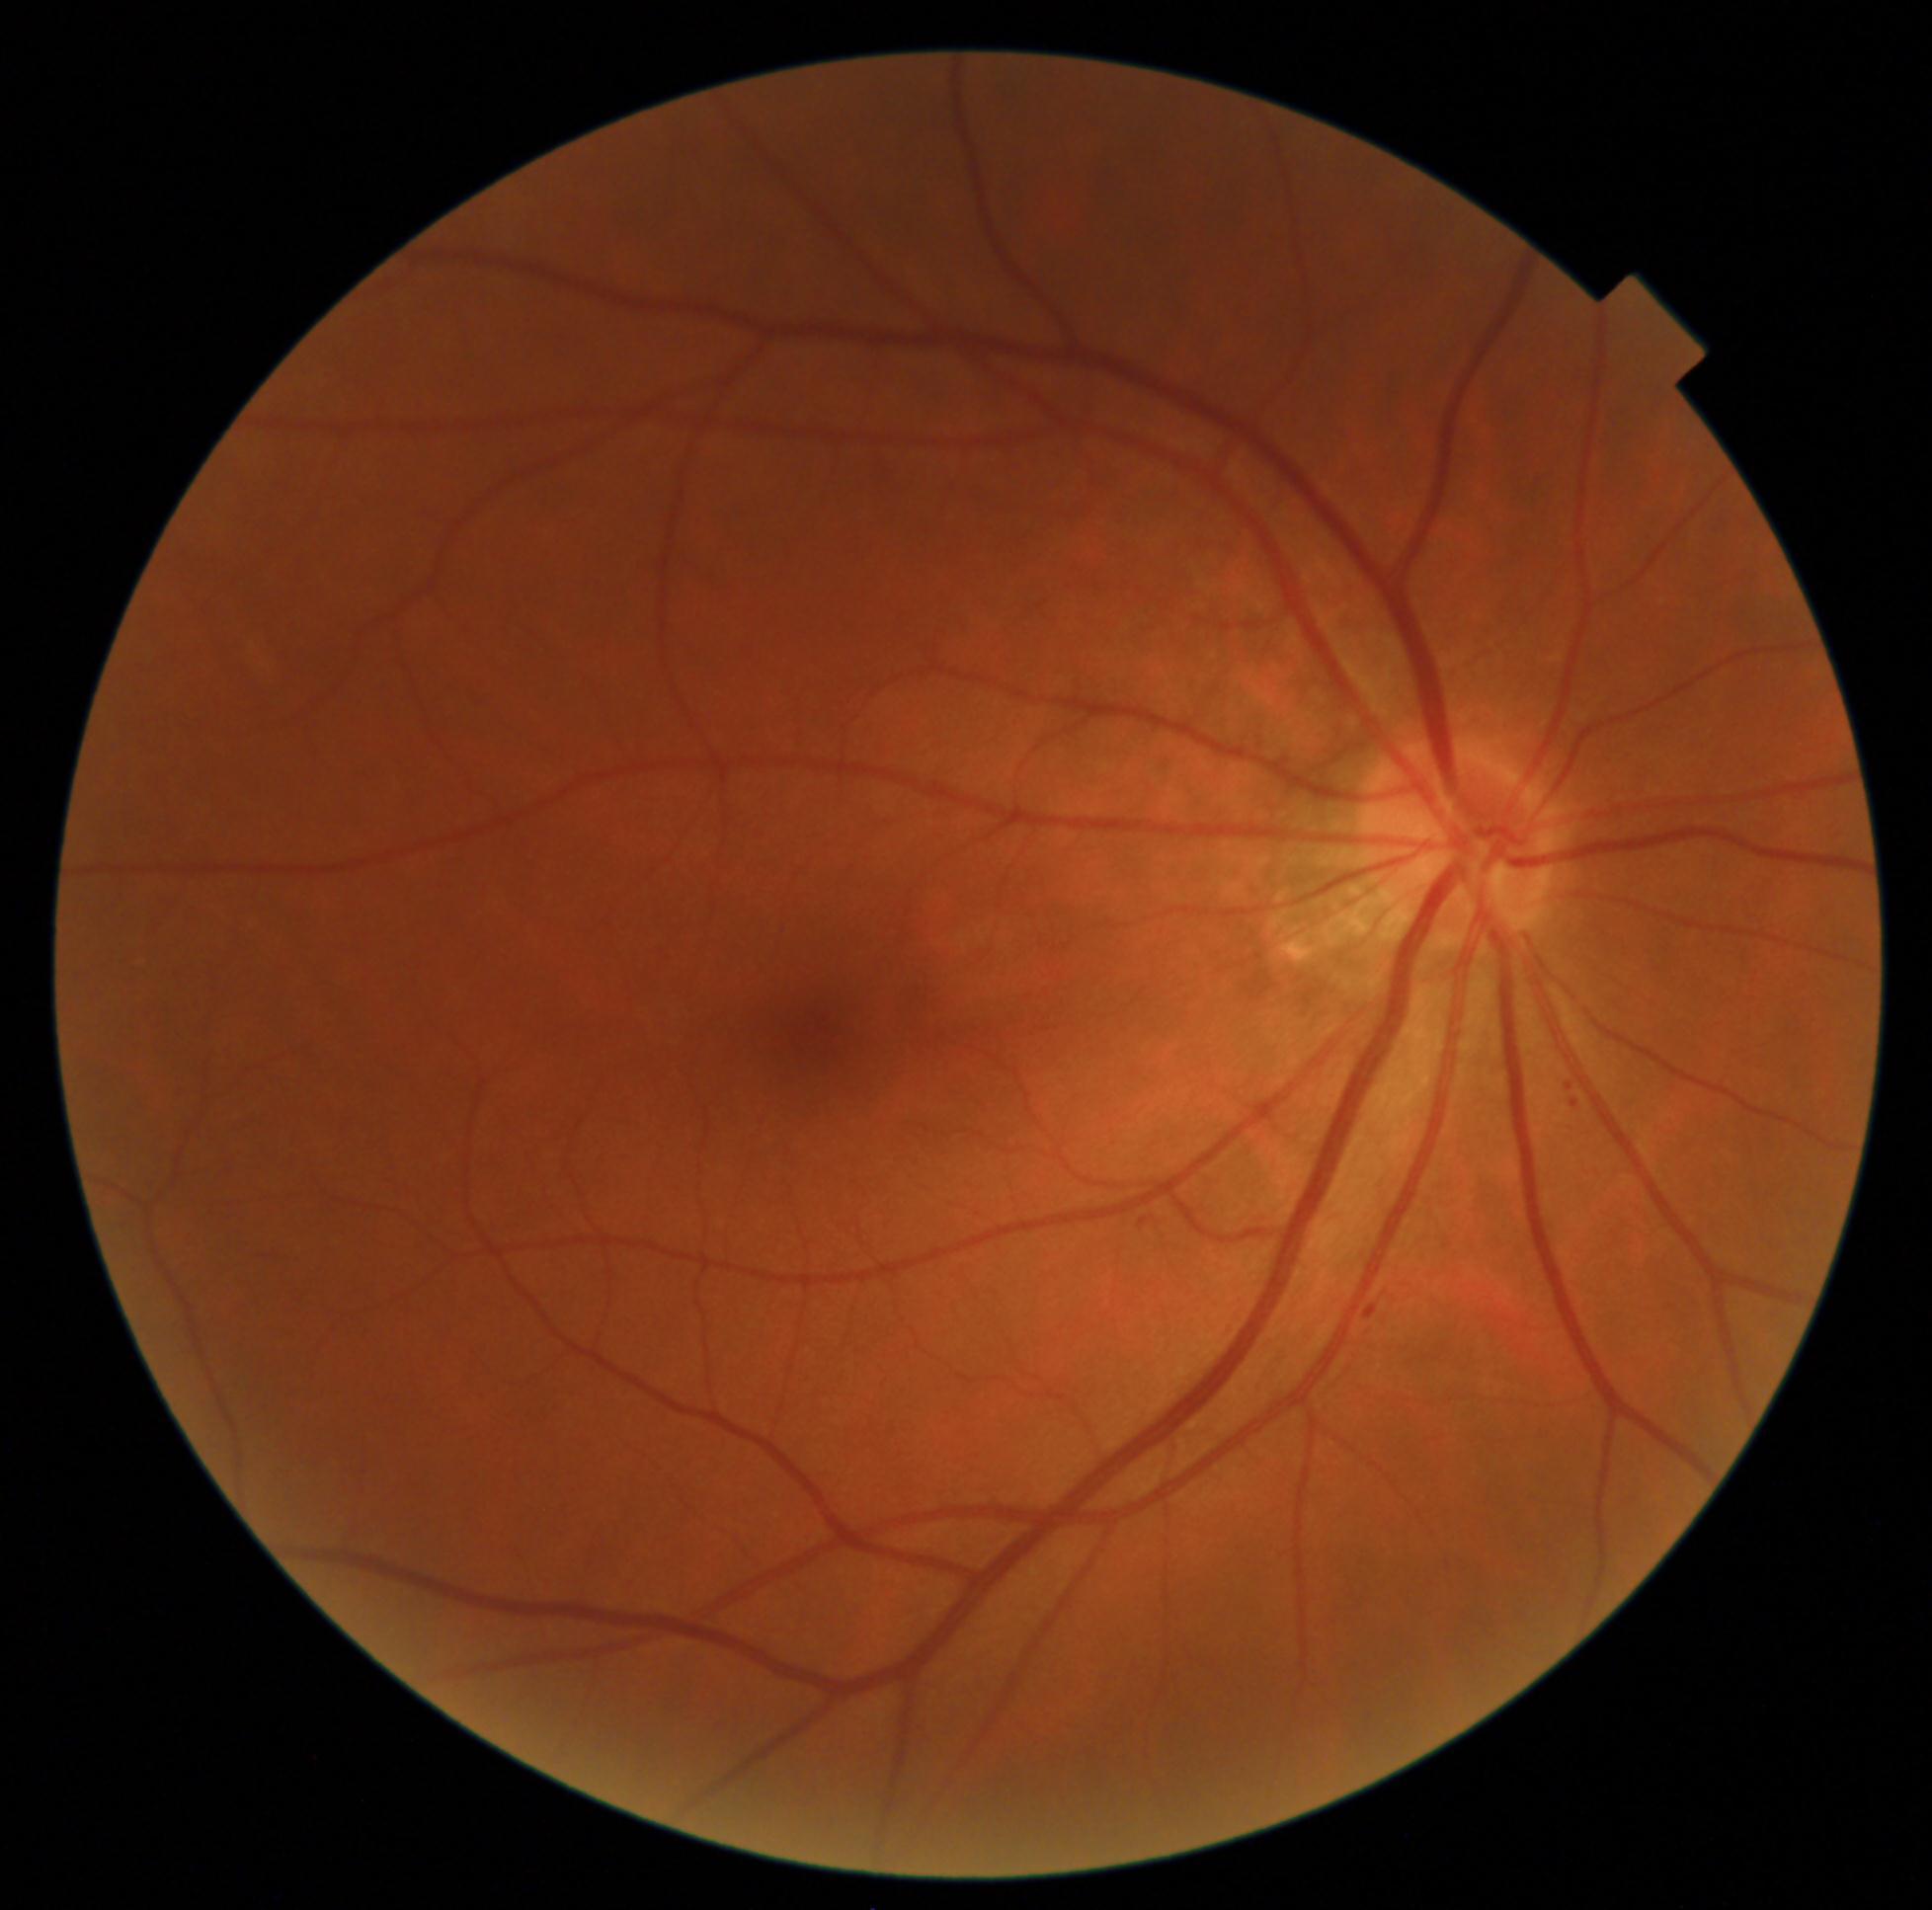

DR stage is 2/4.